Infant wide-field fundus photograph:
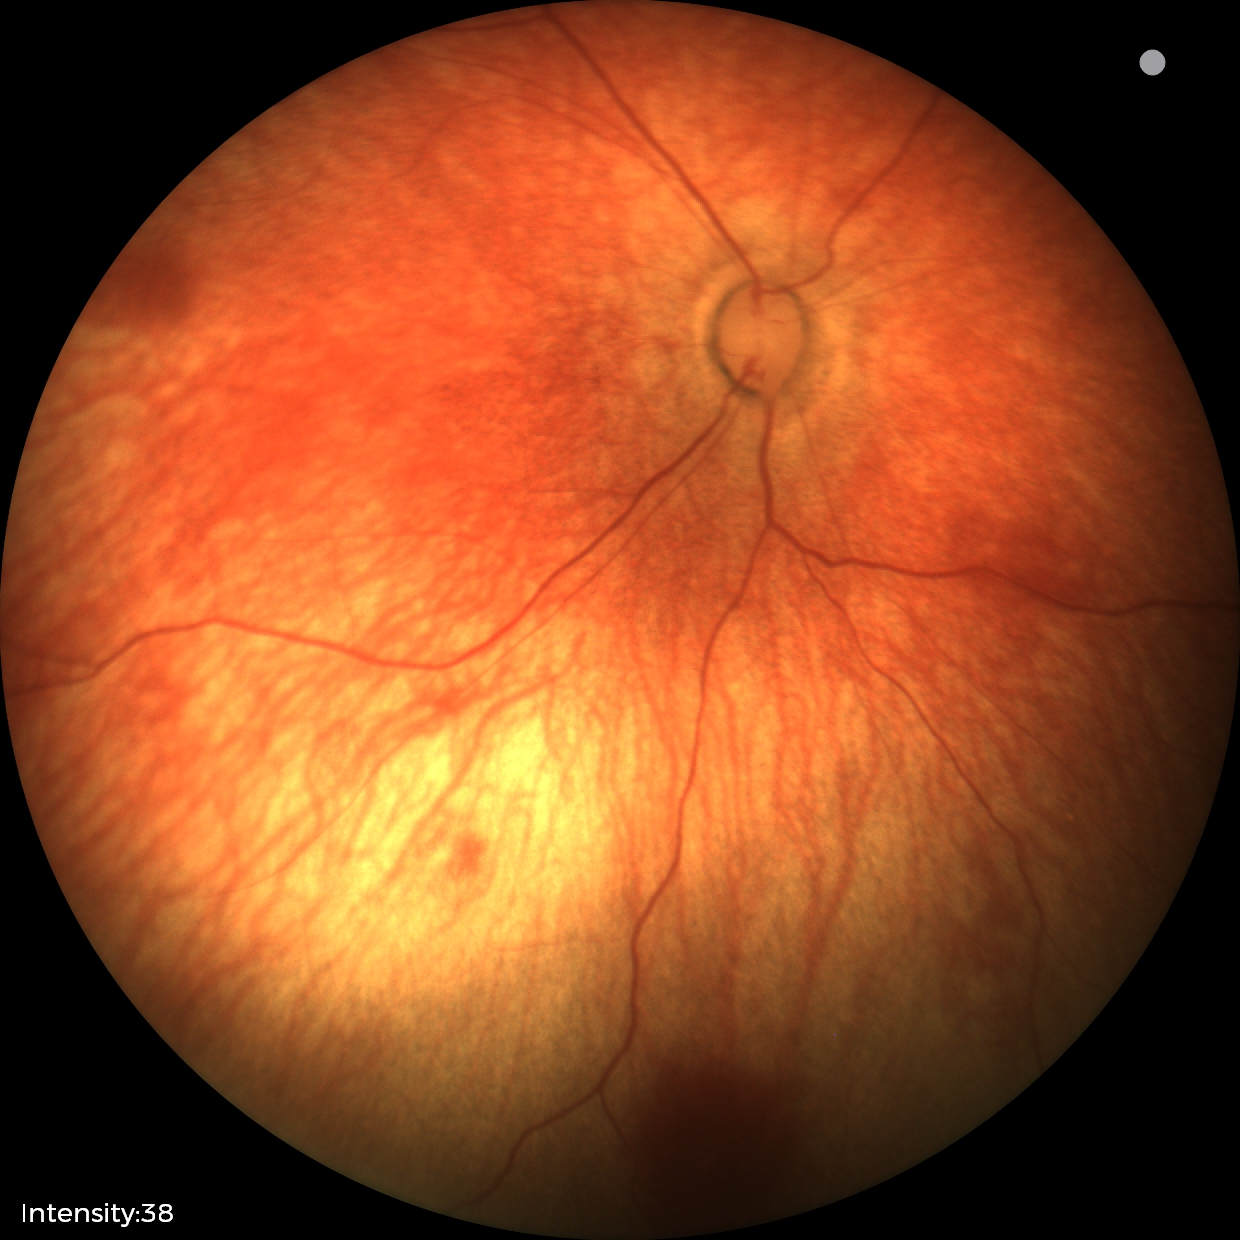

Normal screening examination.